Color fundus image:
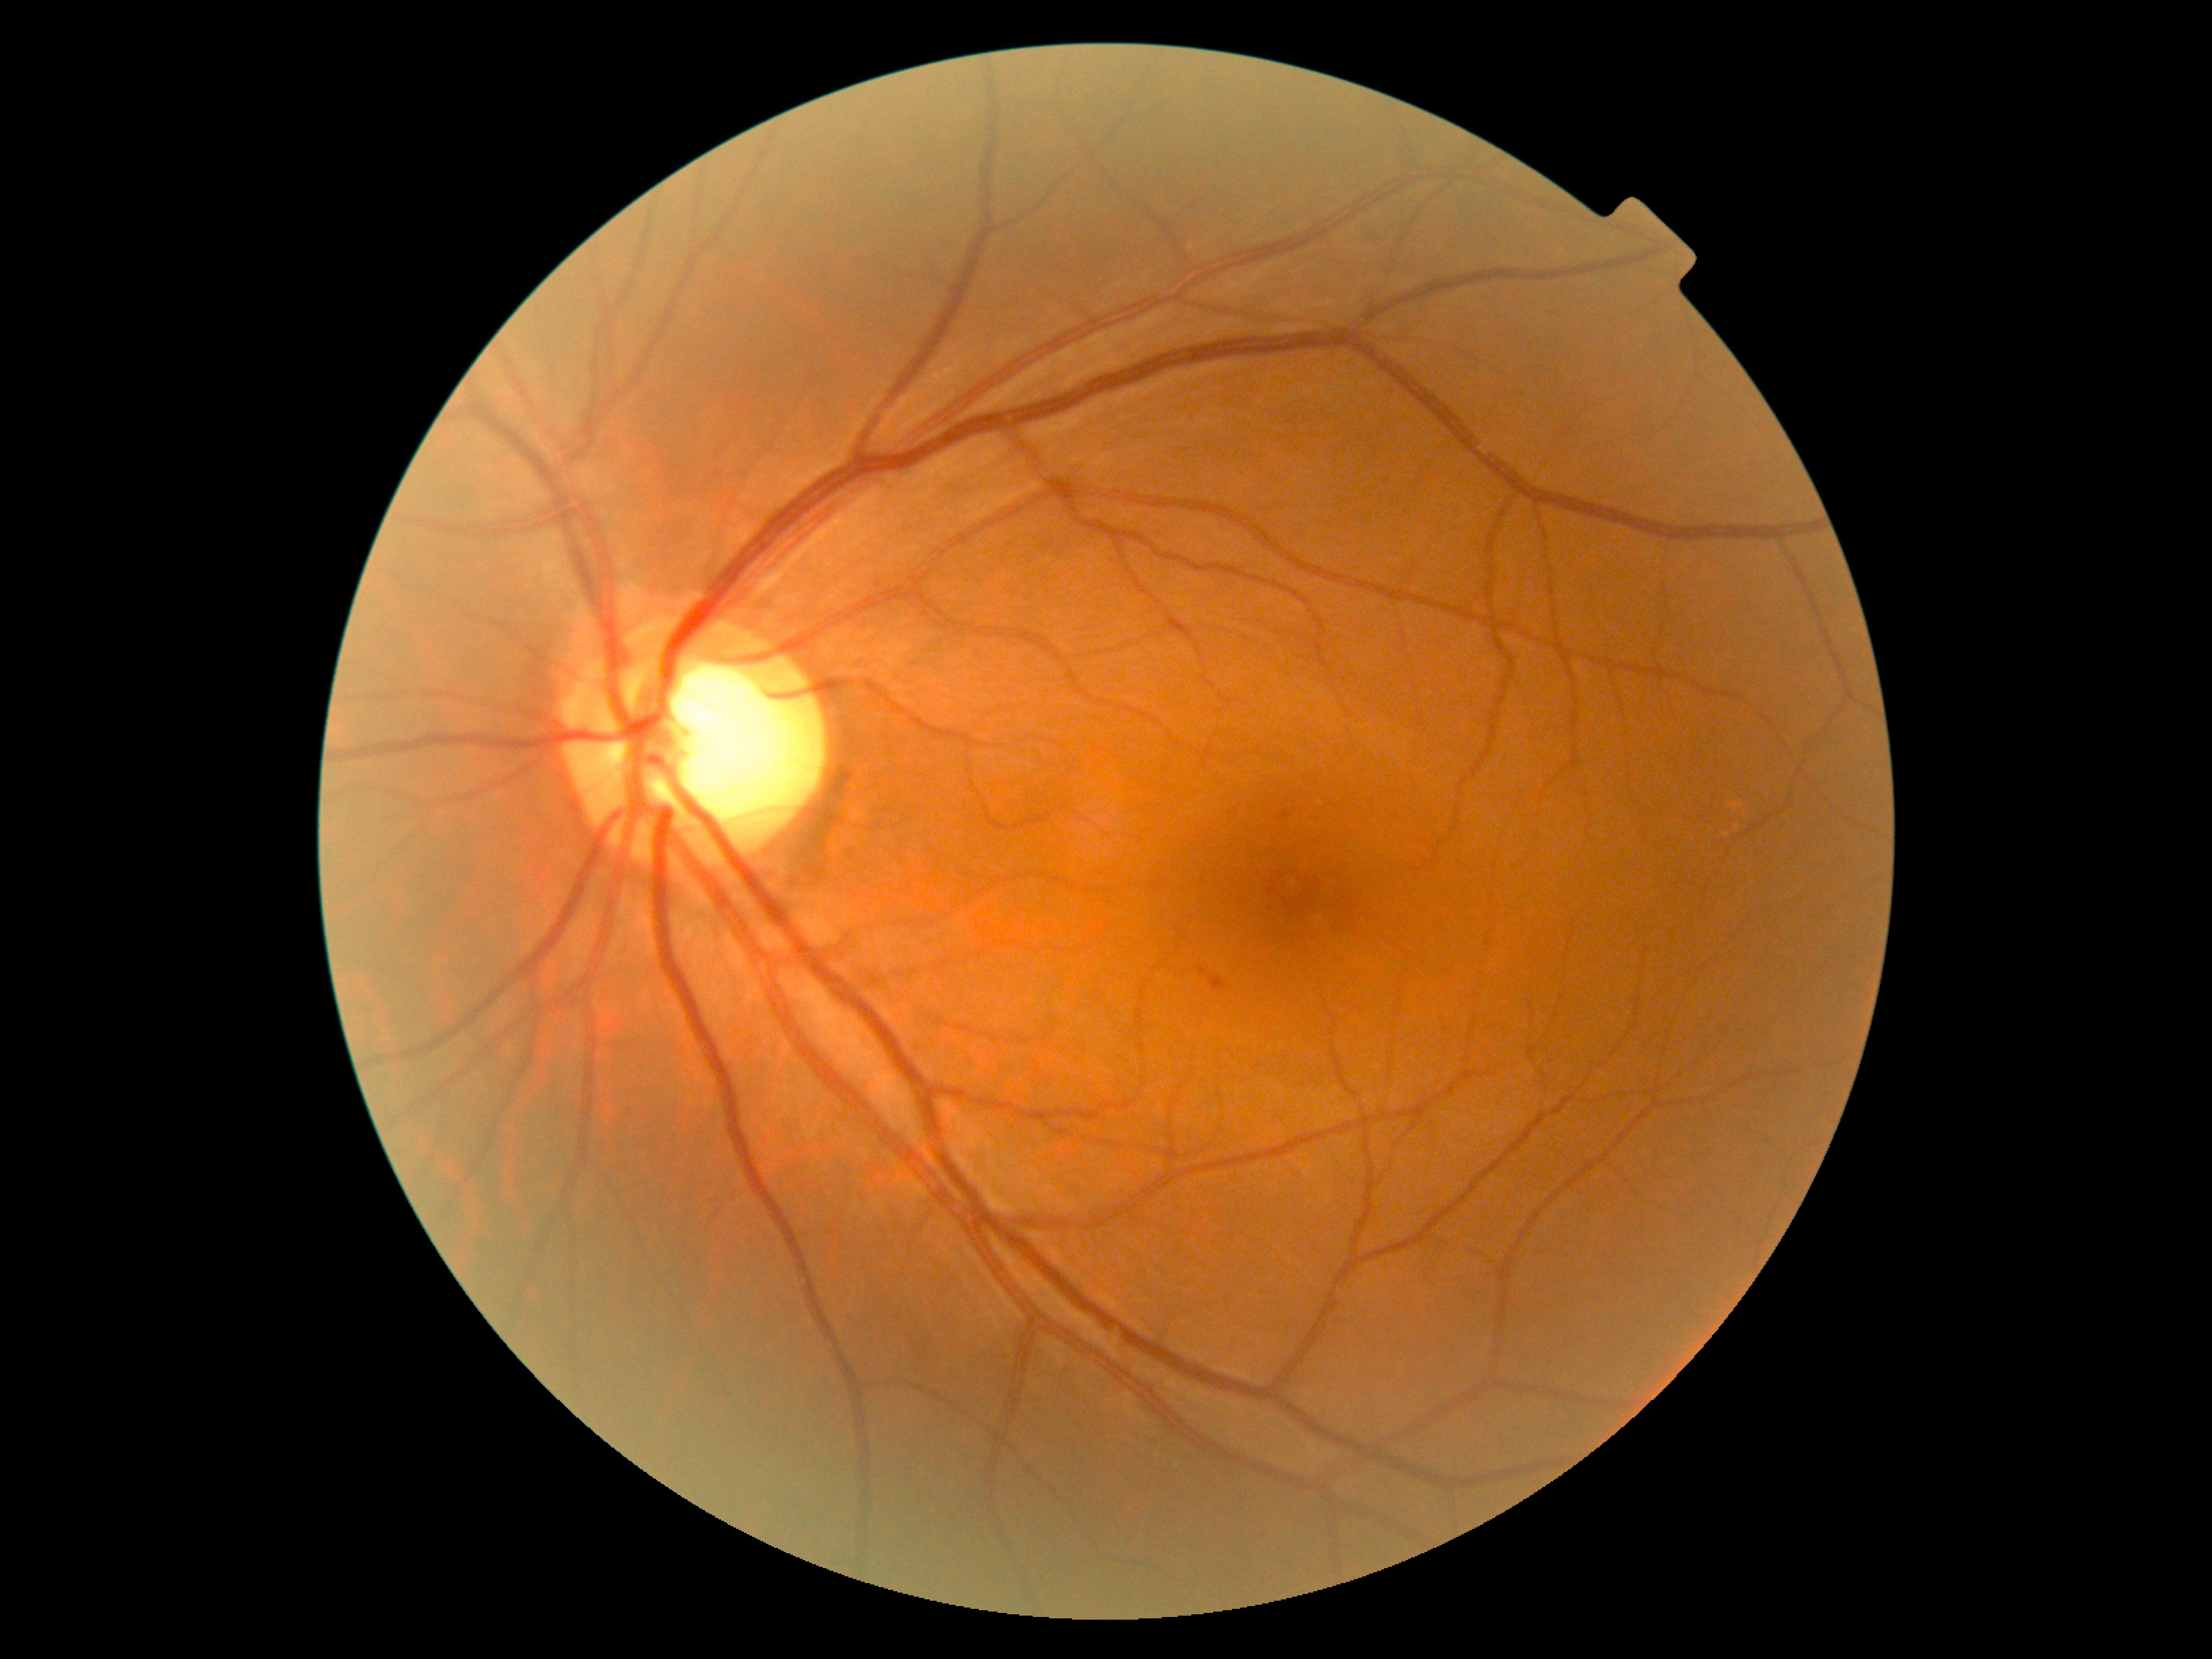

DR stage is moderate NPDR (grade 2). DR class: non-proliferative diabetic retinopathy.